Mydriatic (tropicamide phenylephrine 1.0%):
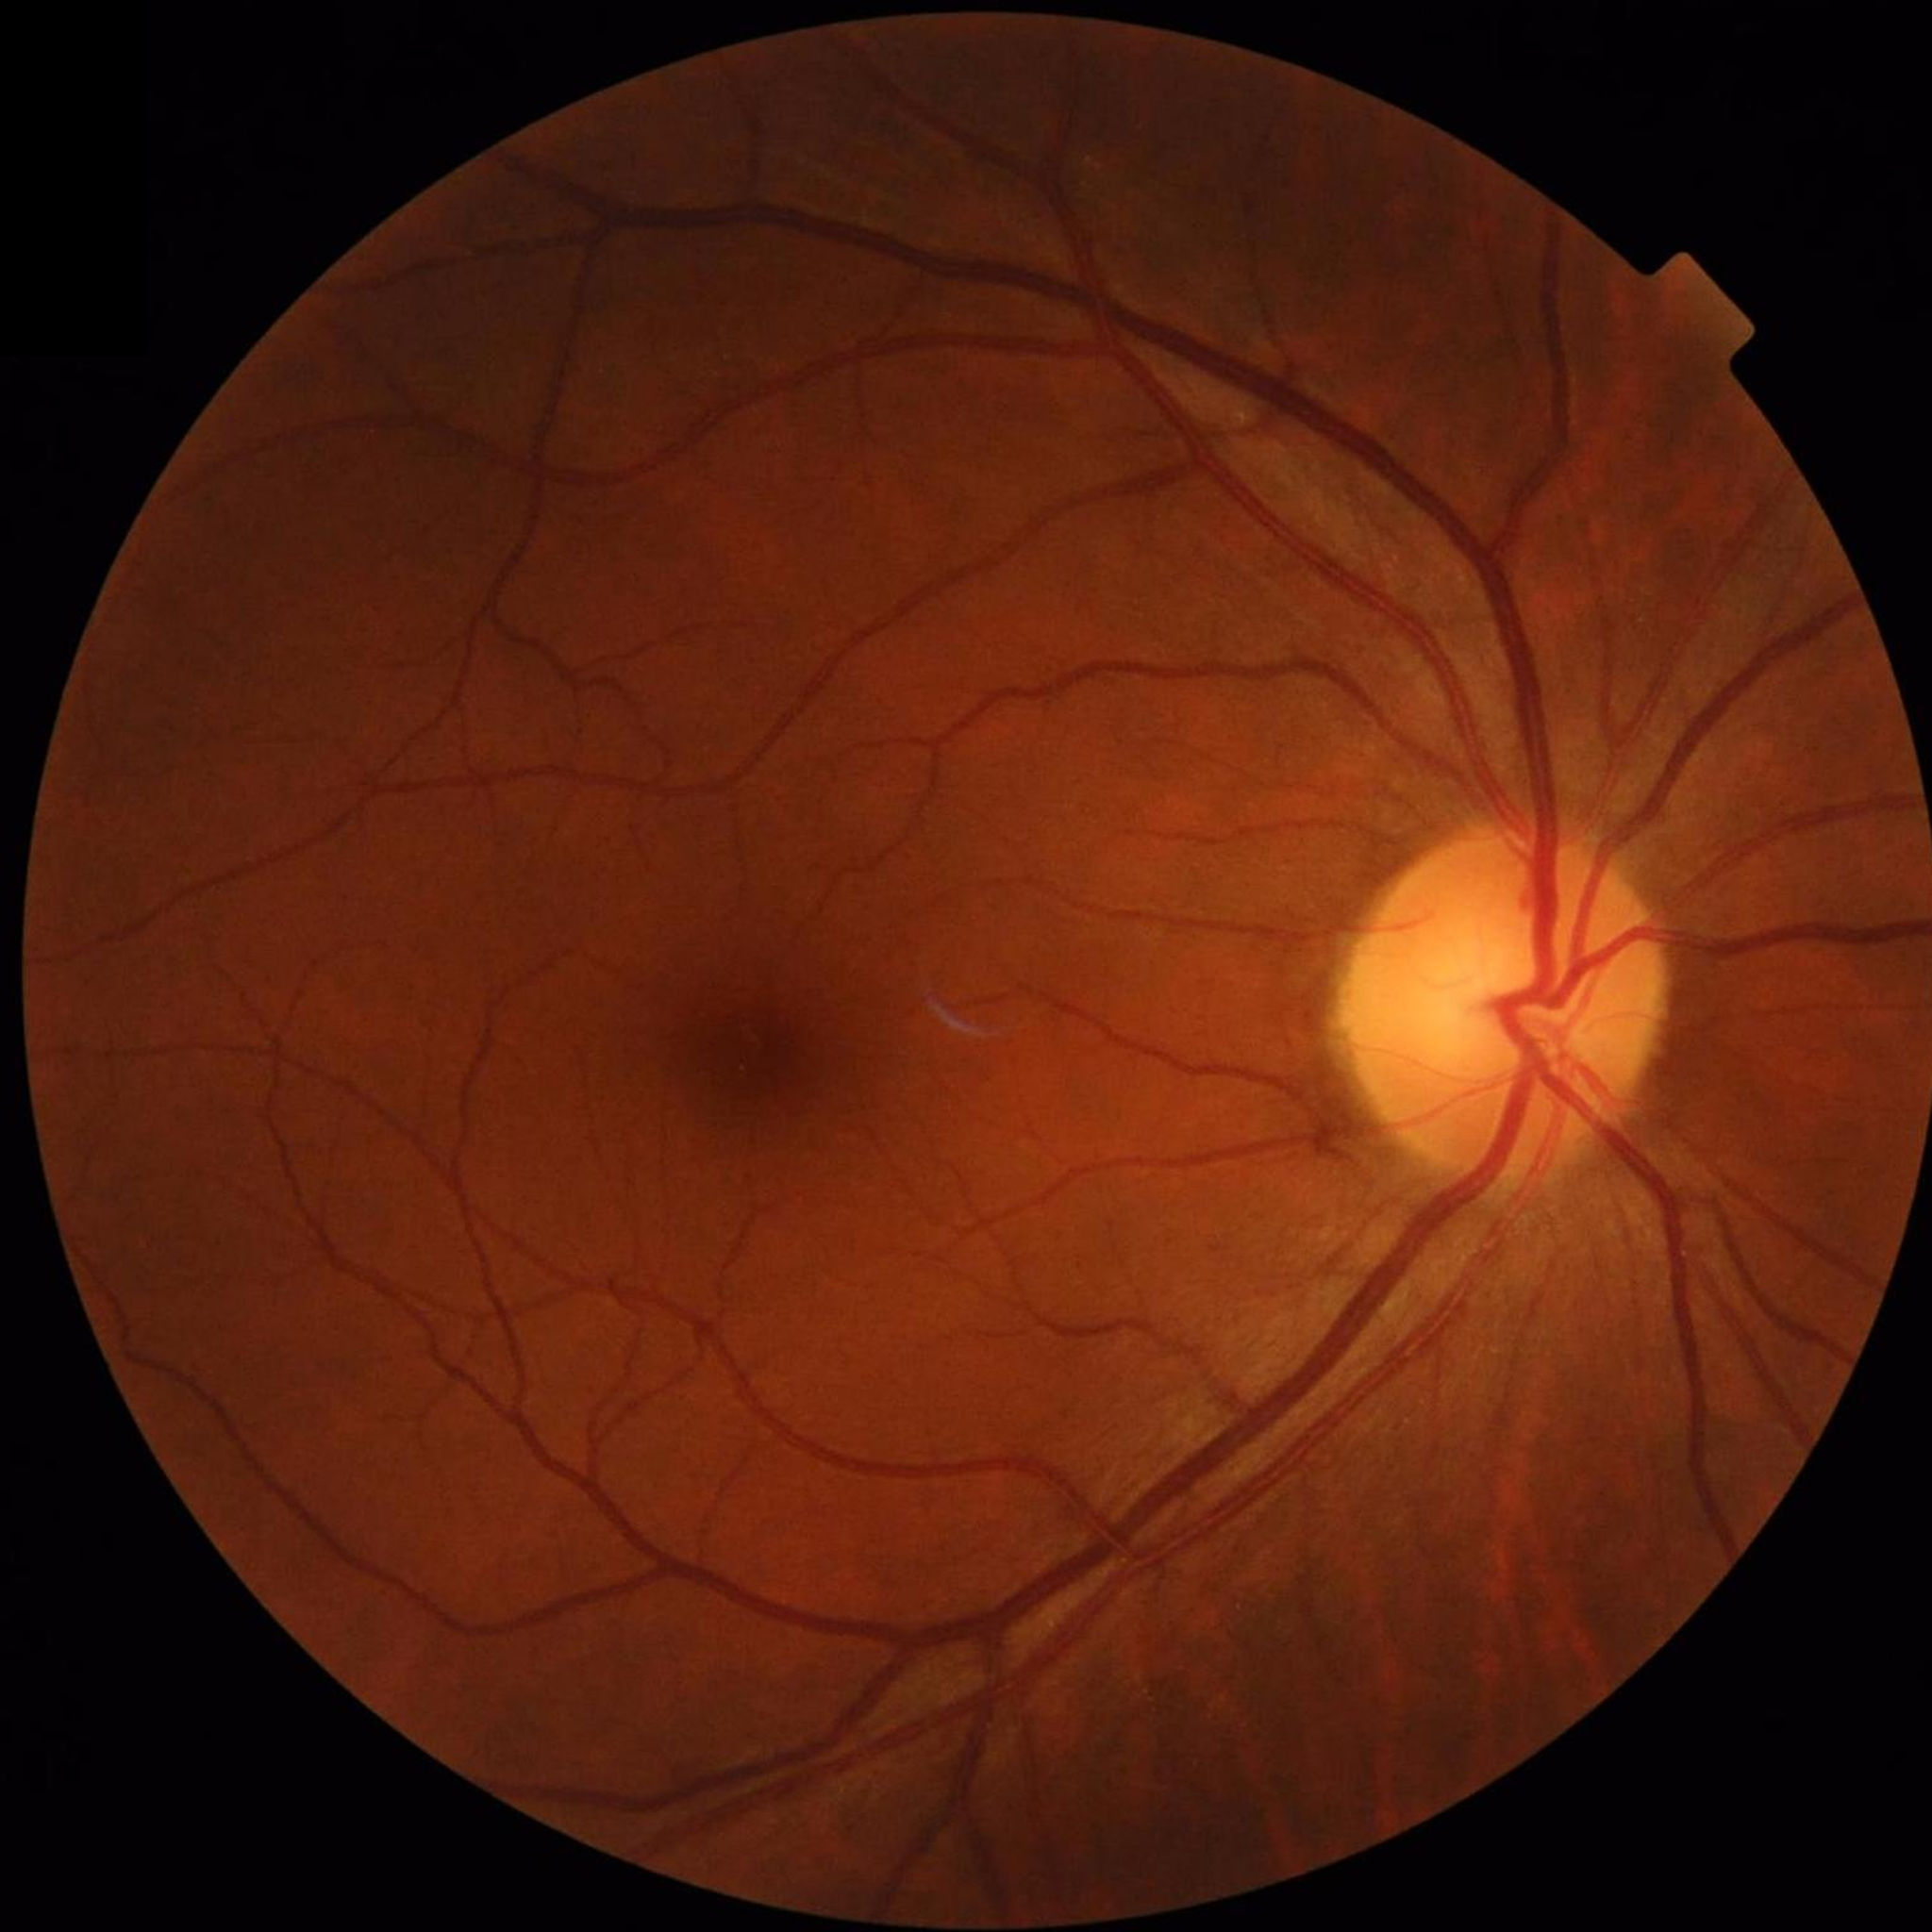

Fundus image with no AMD, diabetic retinopathy, or glaucomatous findings.